45° field of view; color fundus image; 2352 x 1568 pixels
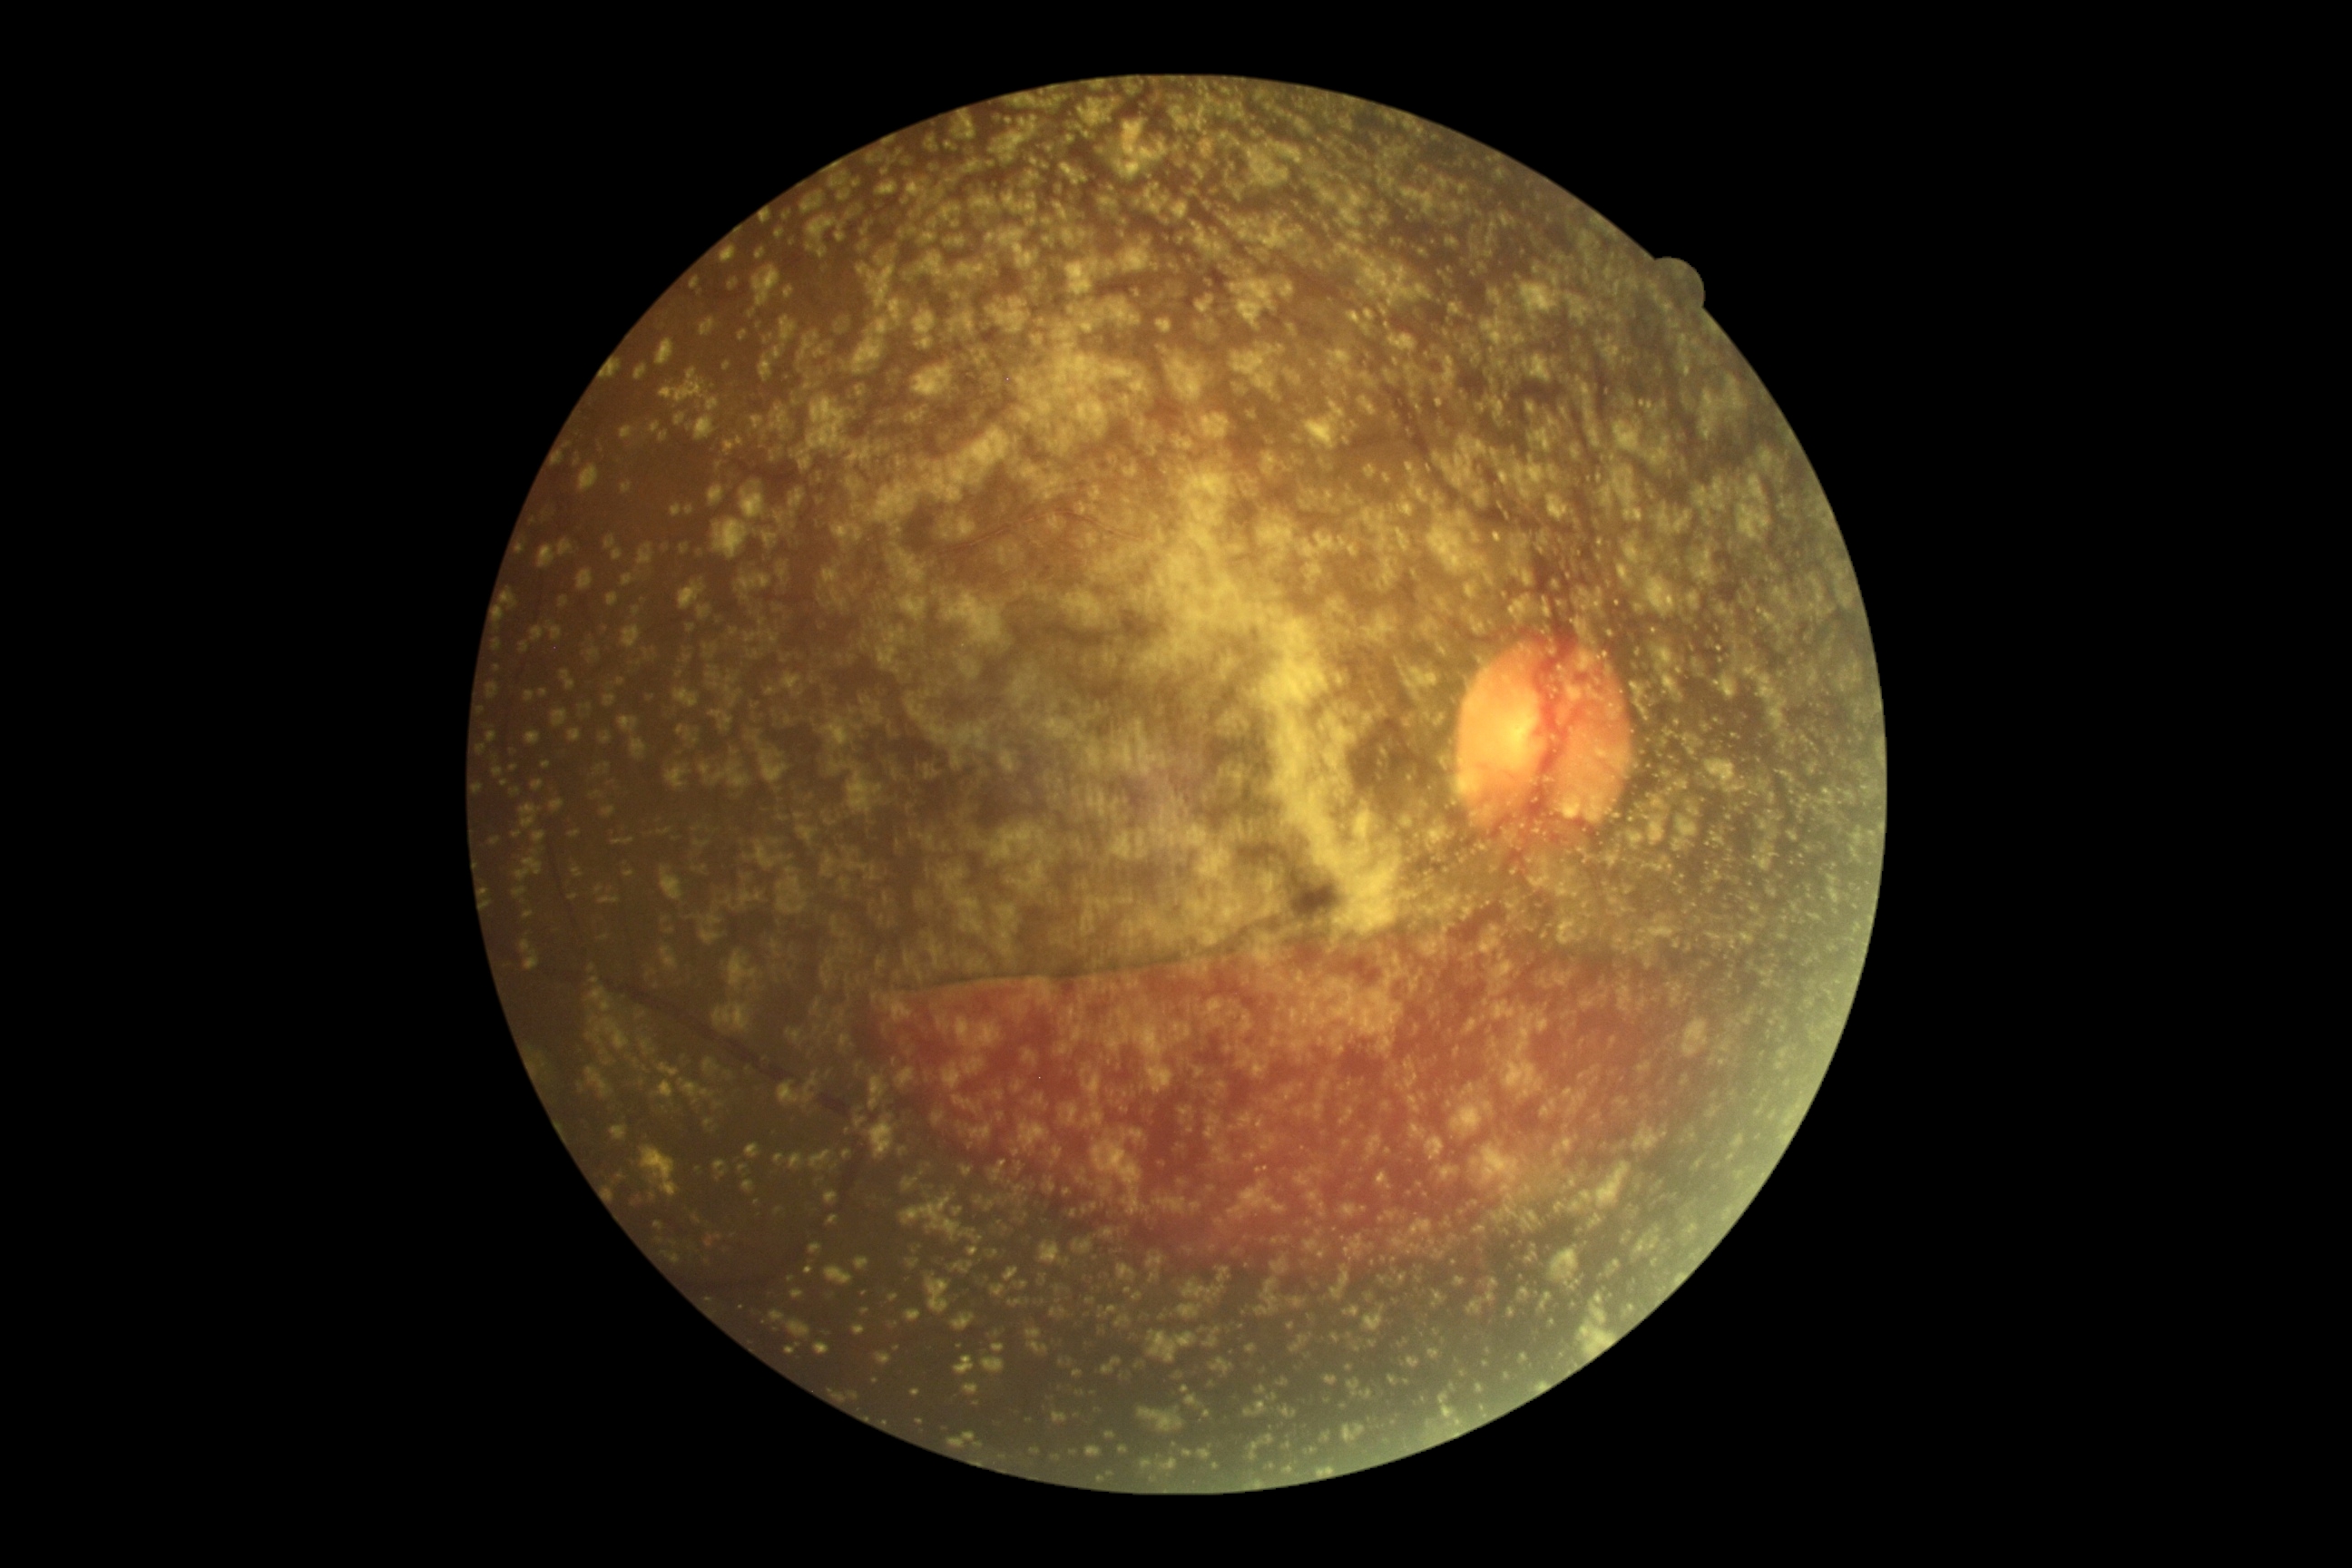
Diabetic retinopathy (DR): 4.